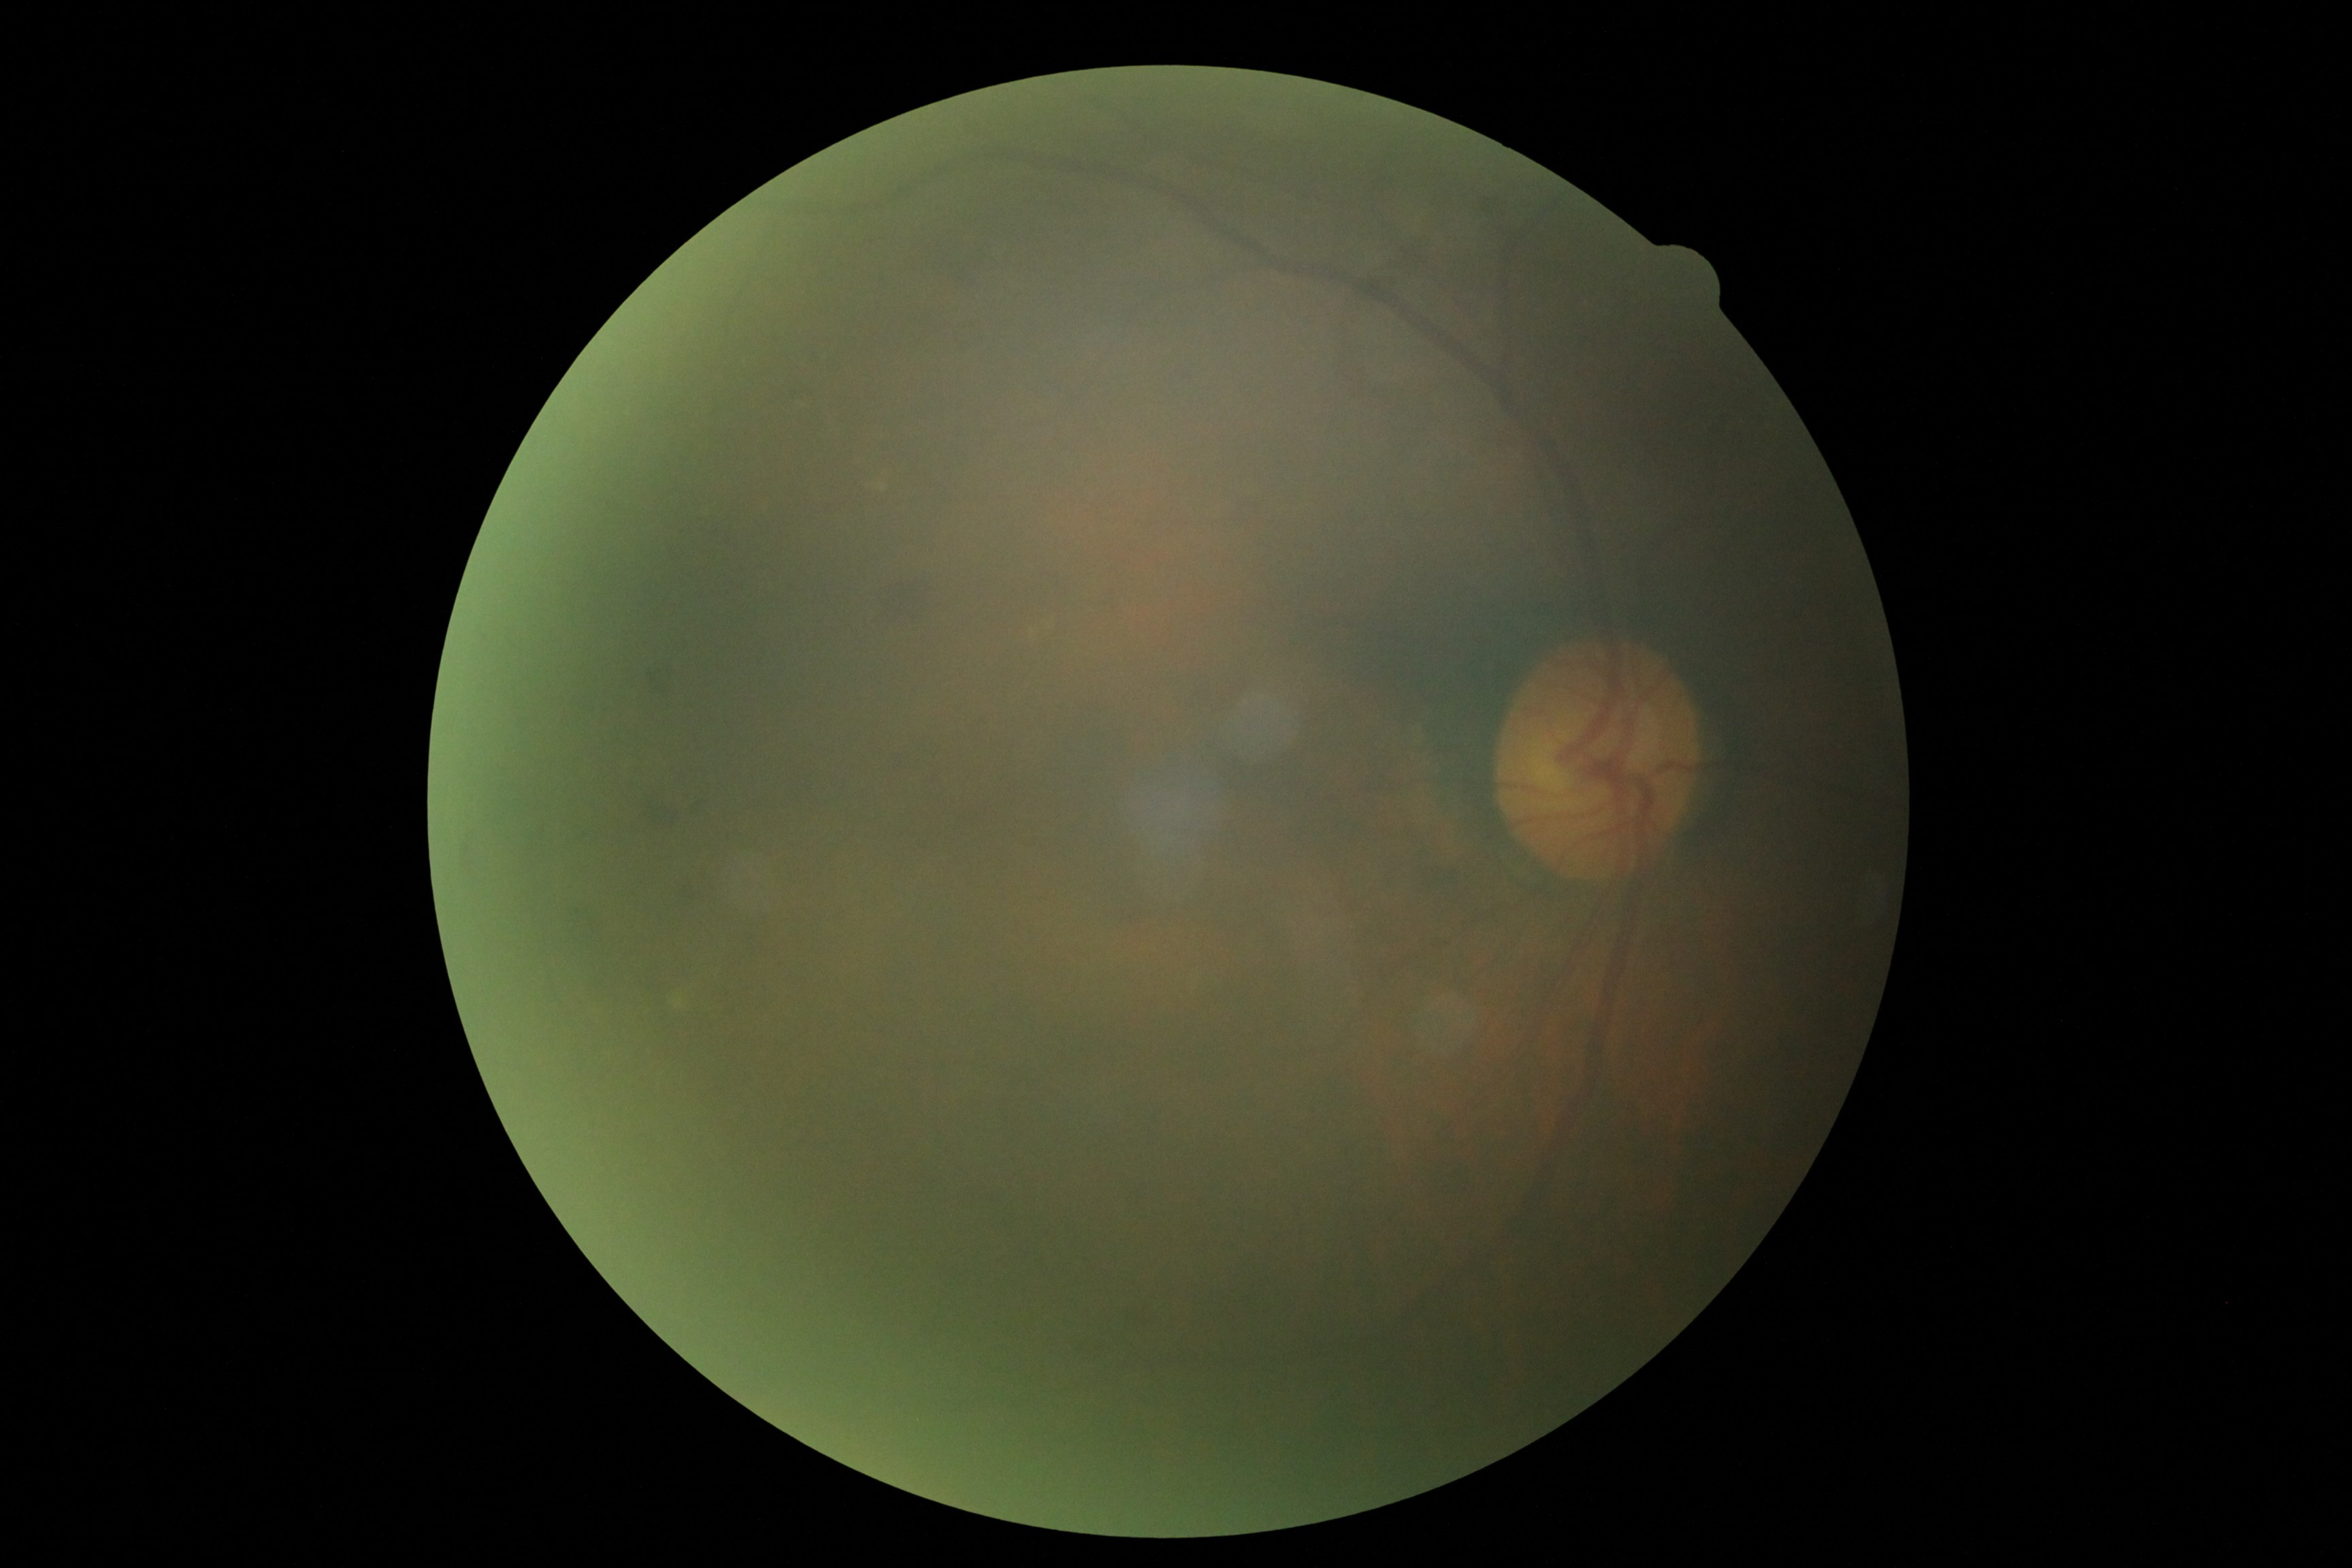
Diabetic retinopathy (DR): grade 2 (moderate NPDR).